45° FOV; image size 1932x1932; color fundus photograph: 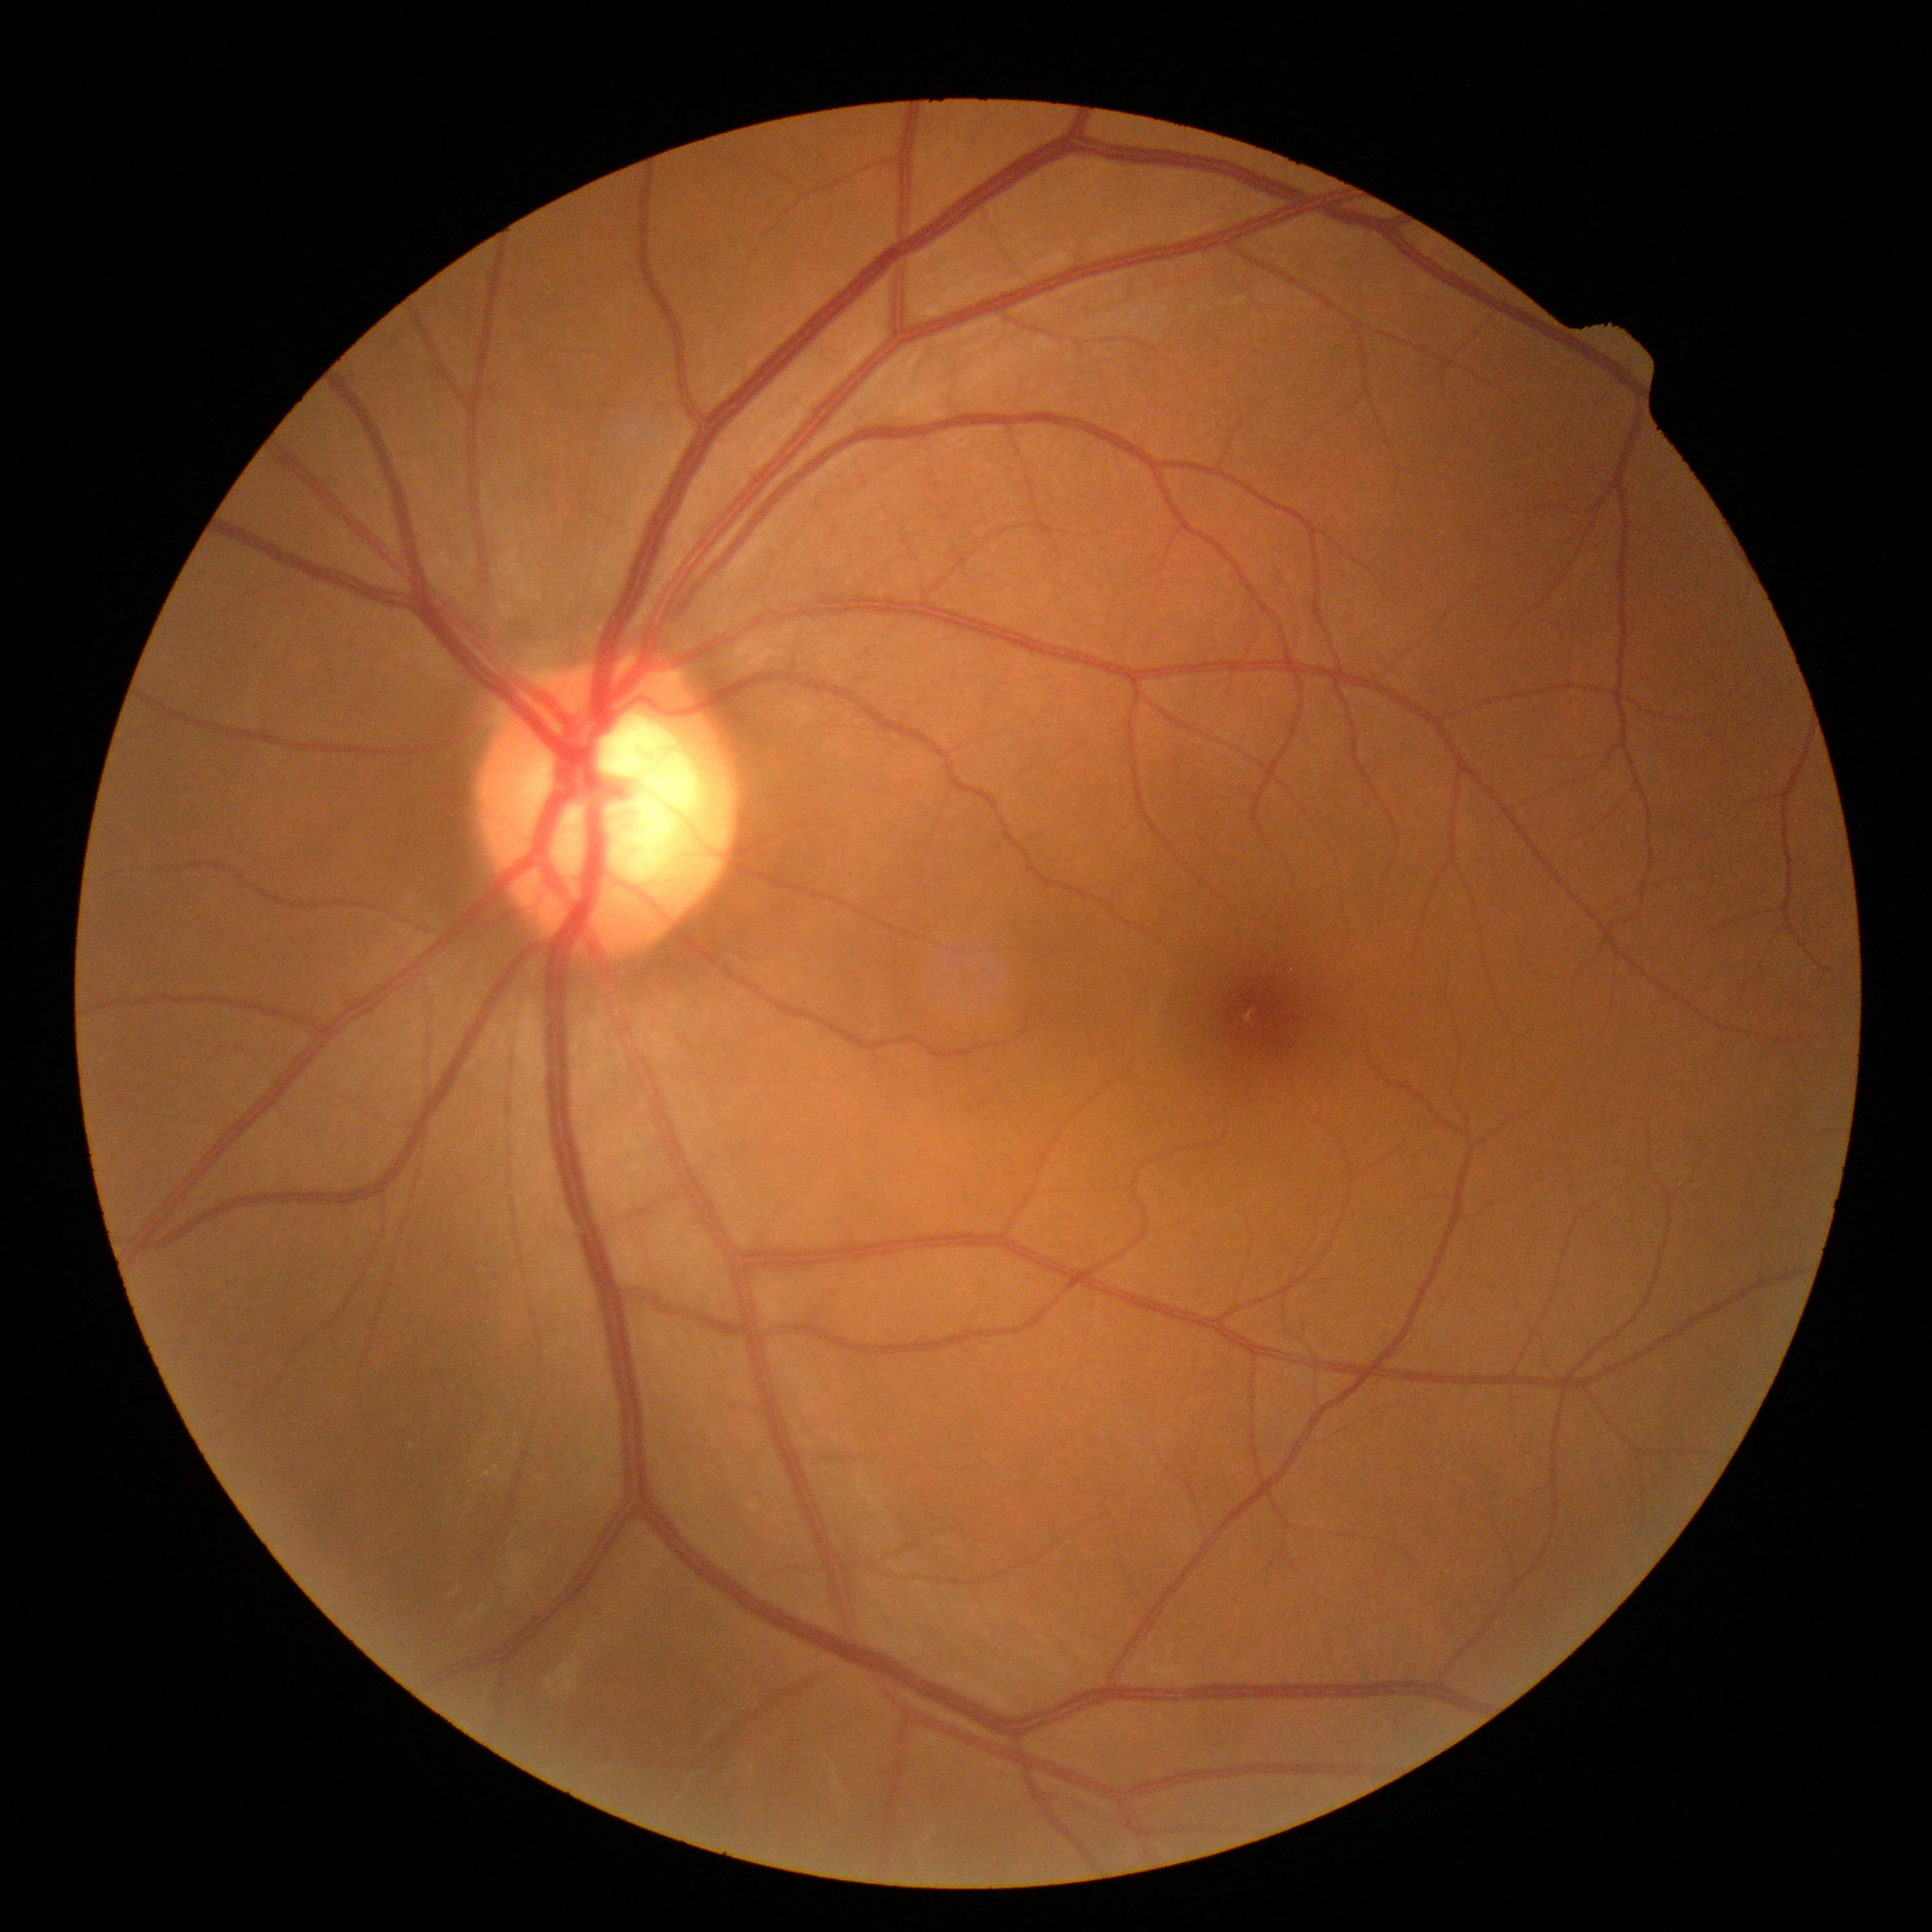
dr_grade: 0